1932x1916px, color fundus photograph — 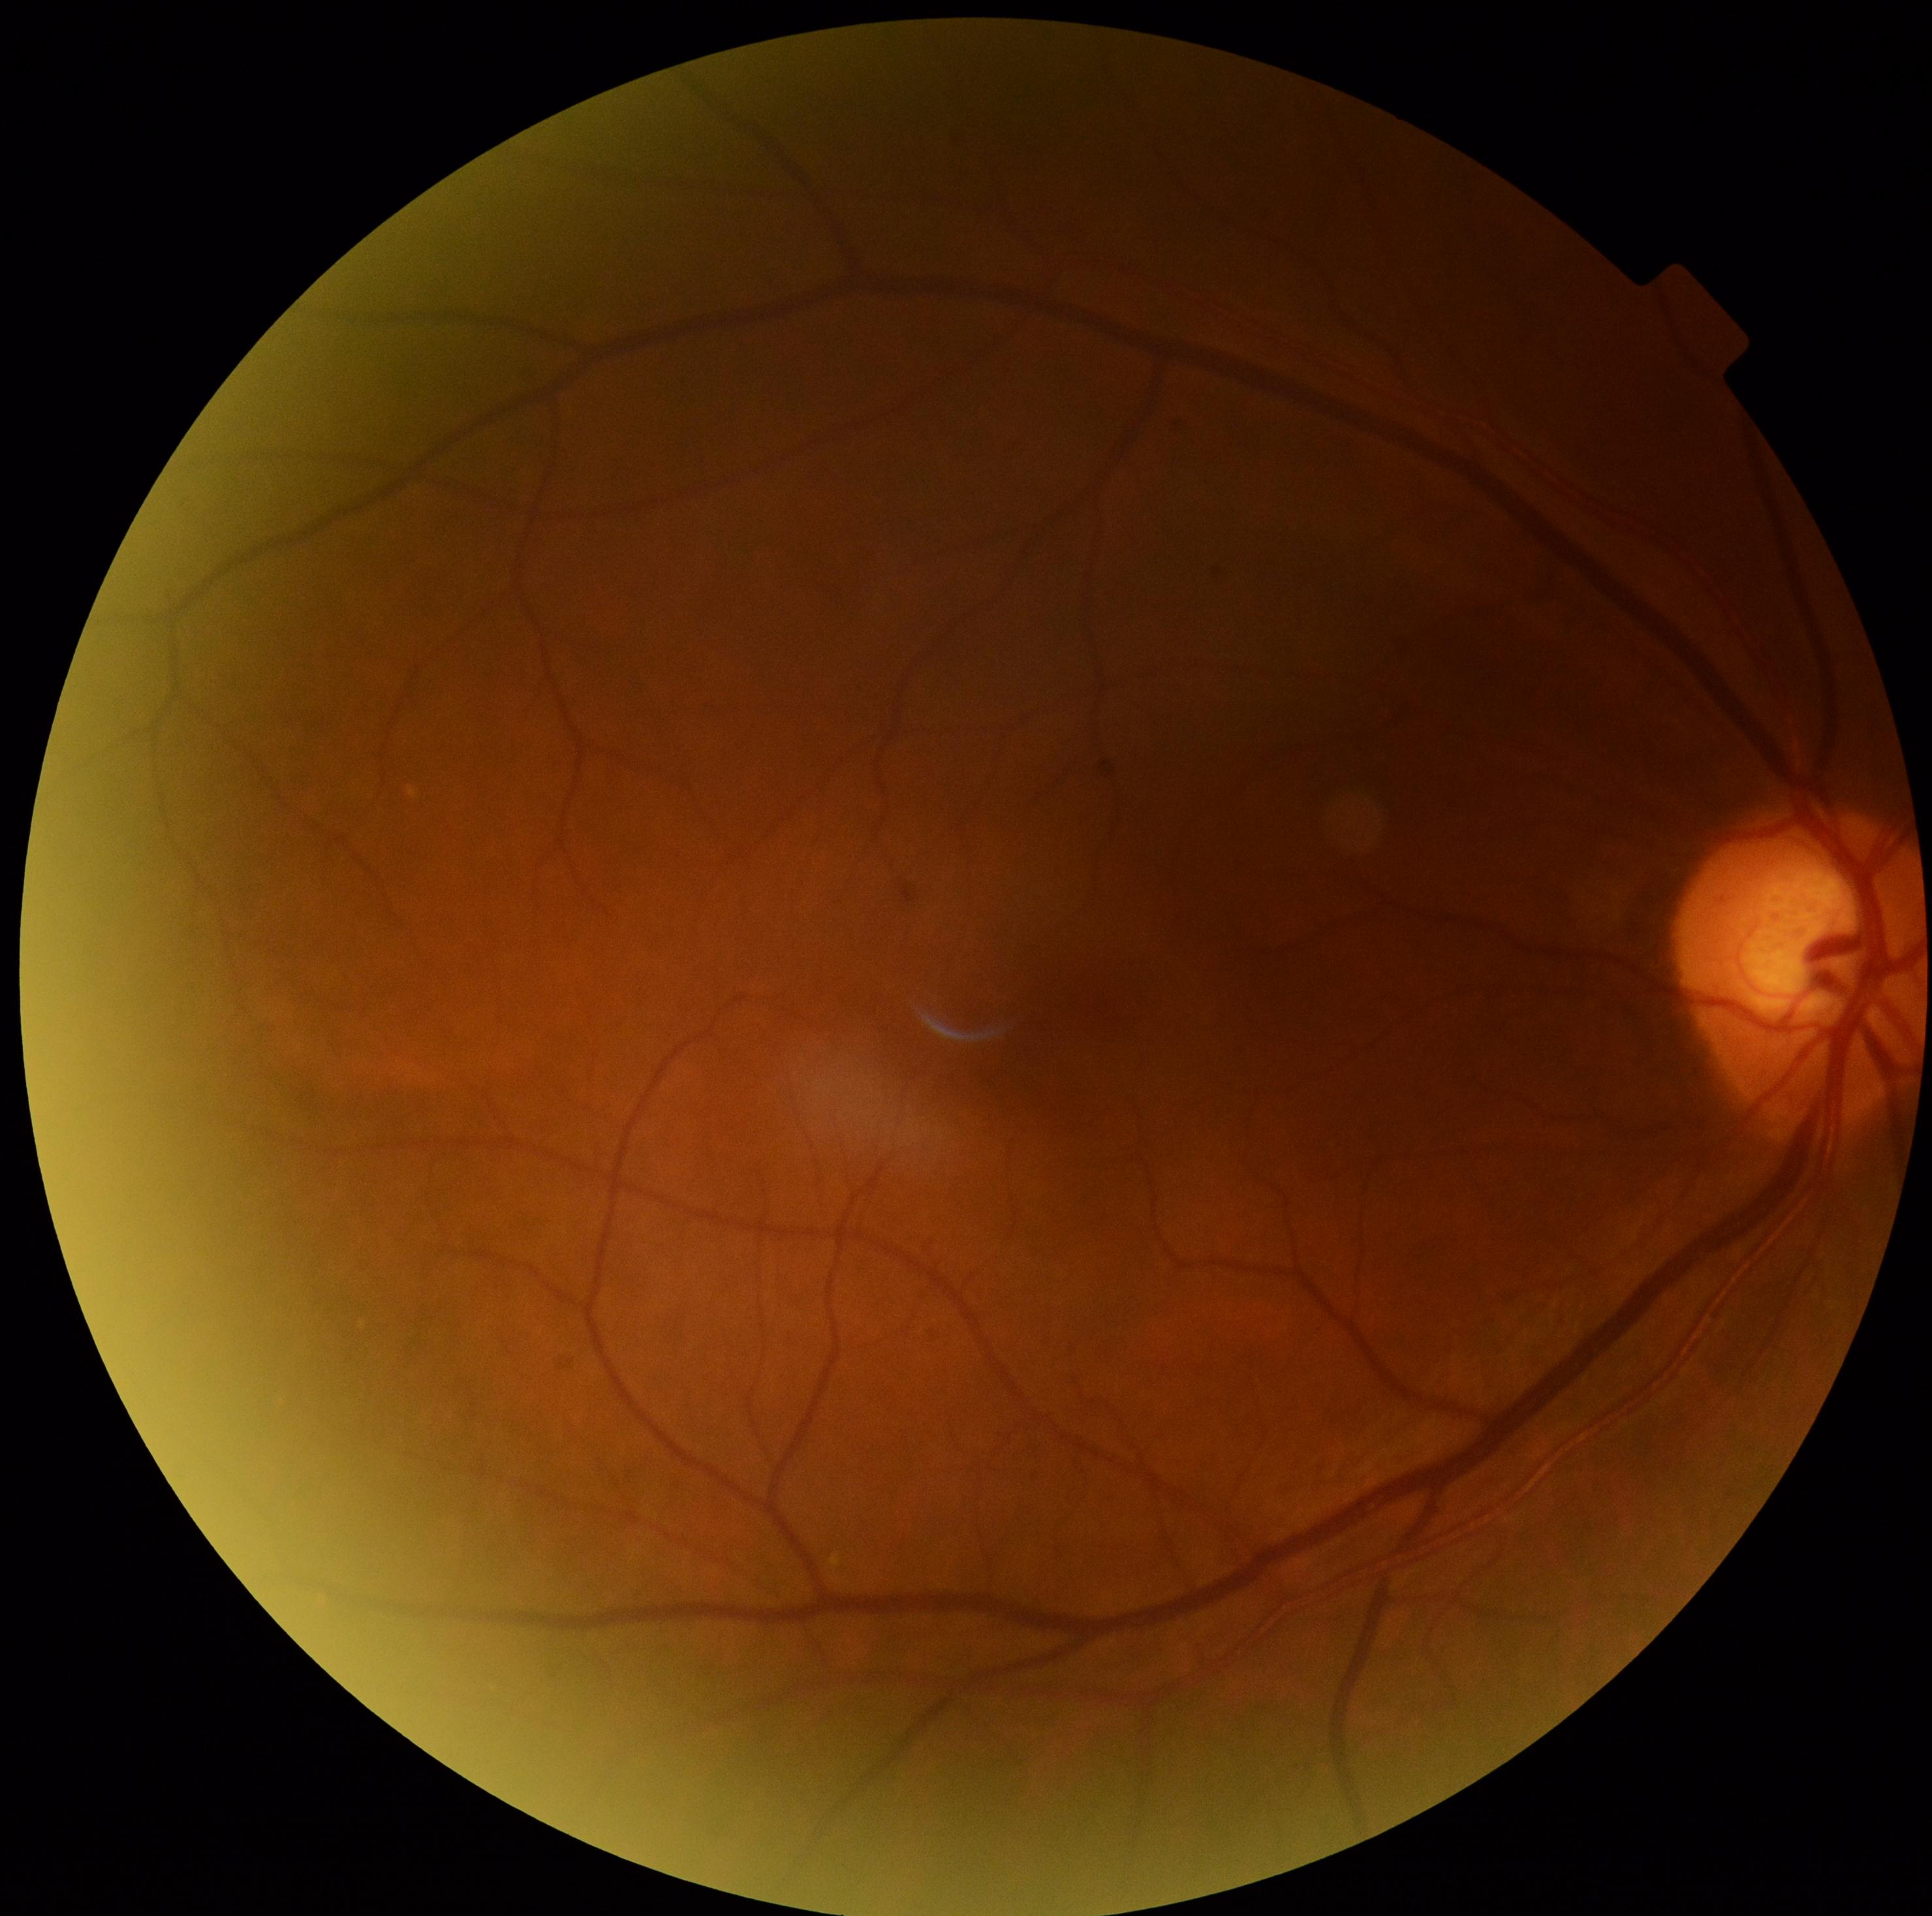
No apparent diabetic retinopathy. DR is no apparent diabetic retinopathy (grade 0).